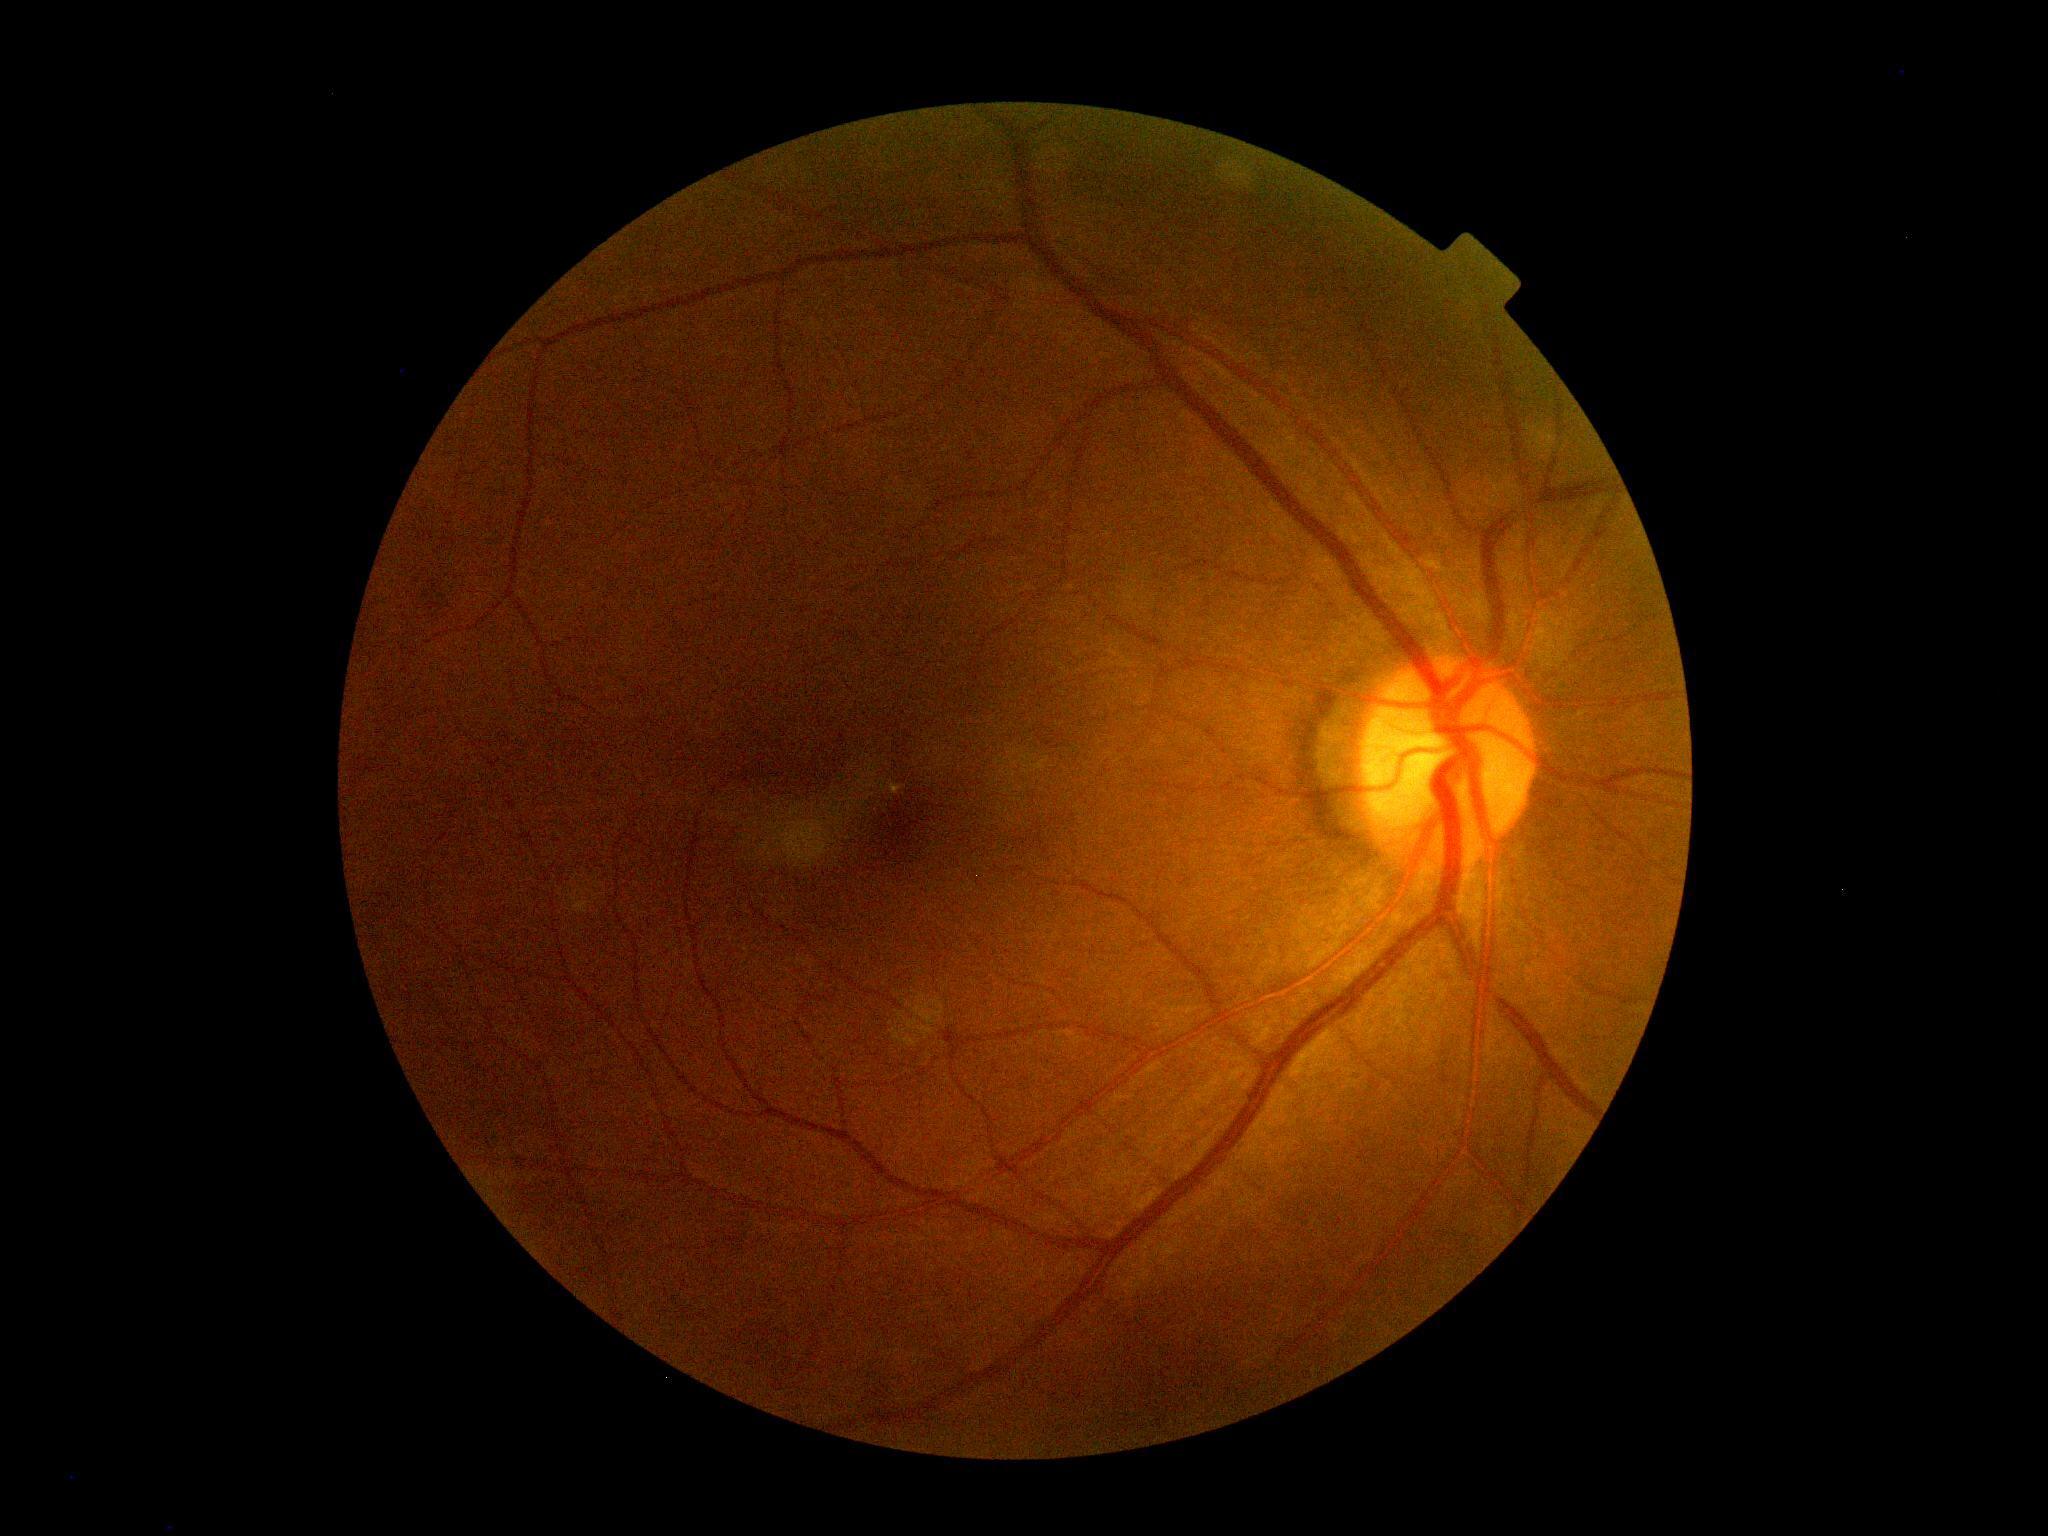
No signs of diabetic retinopathy.
DR grade: 0 (no apparent retinopathy) — no visible signs of diabetic retinopathy.